Intraocular pressure: 18 mmHg · 30° field of view: 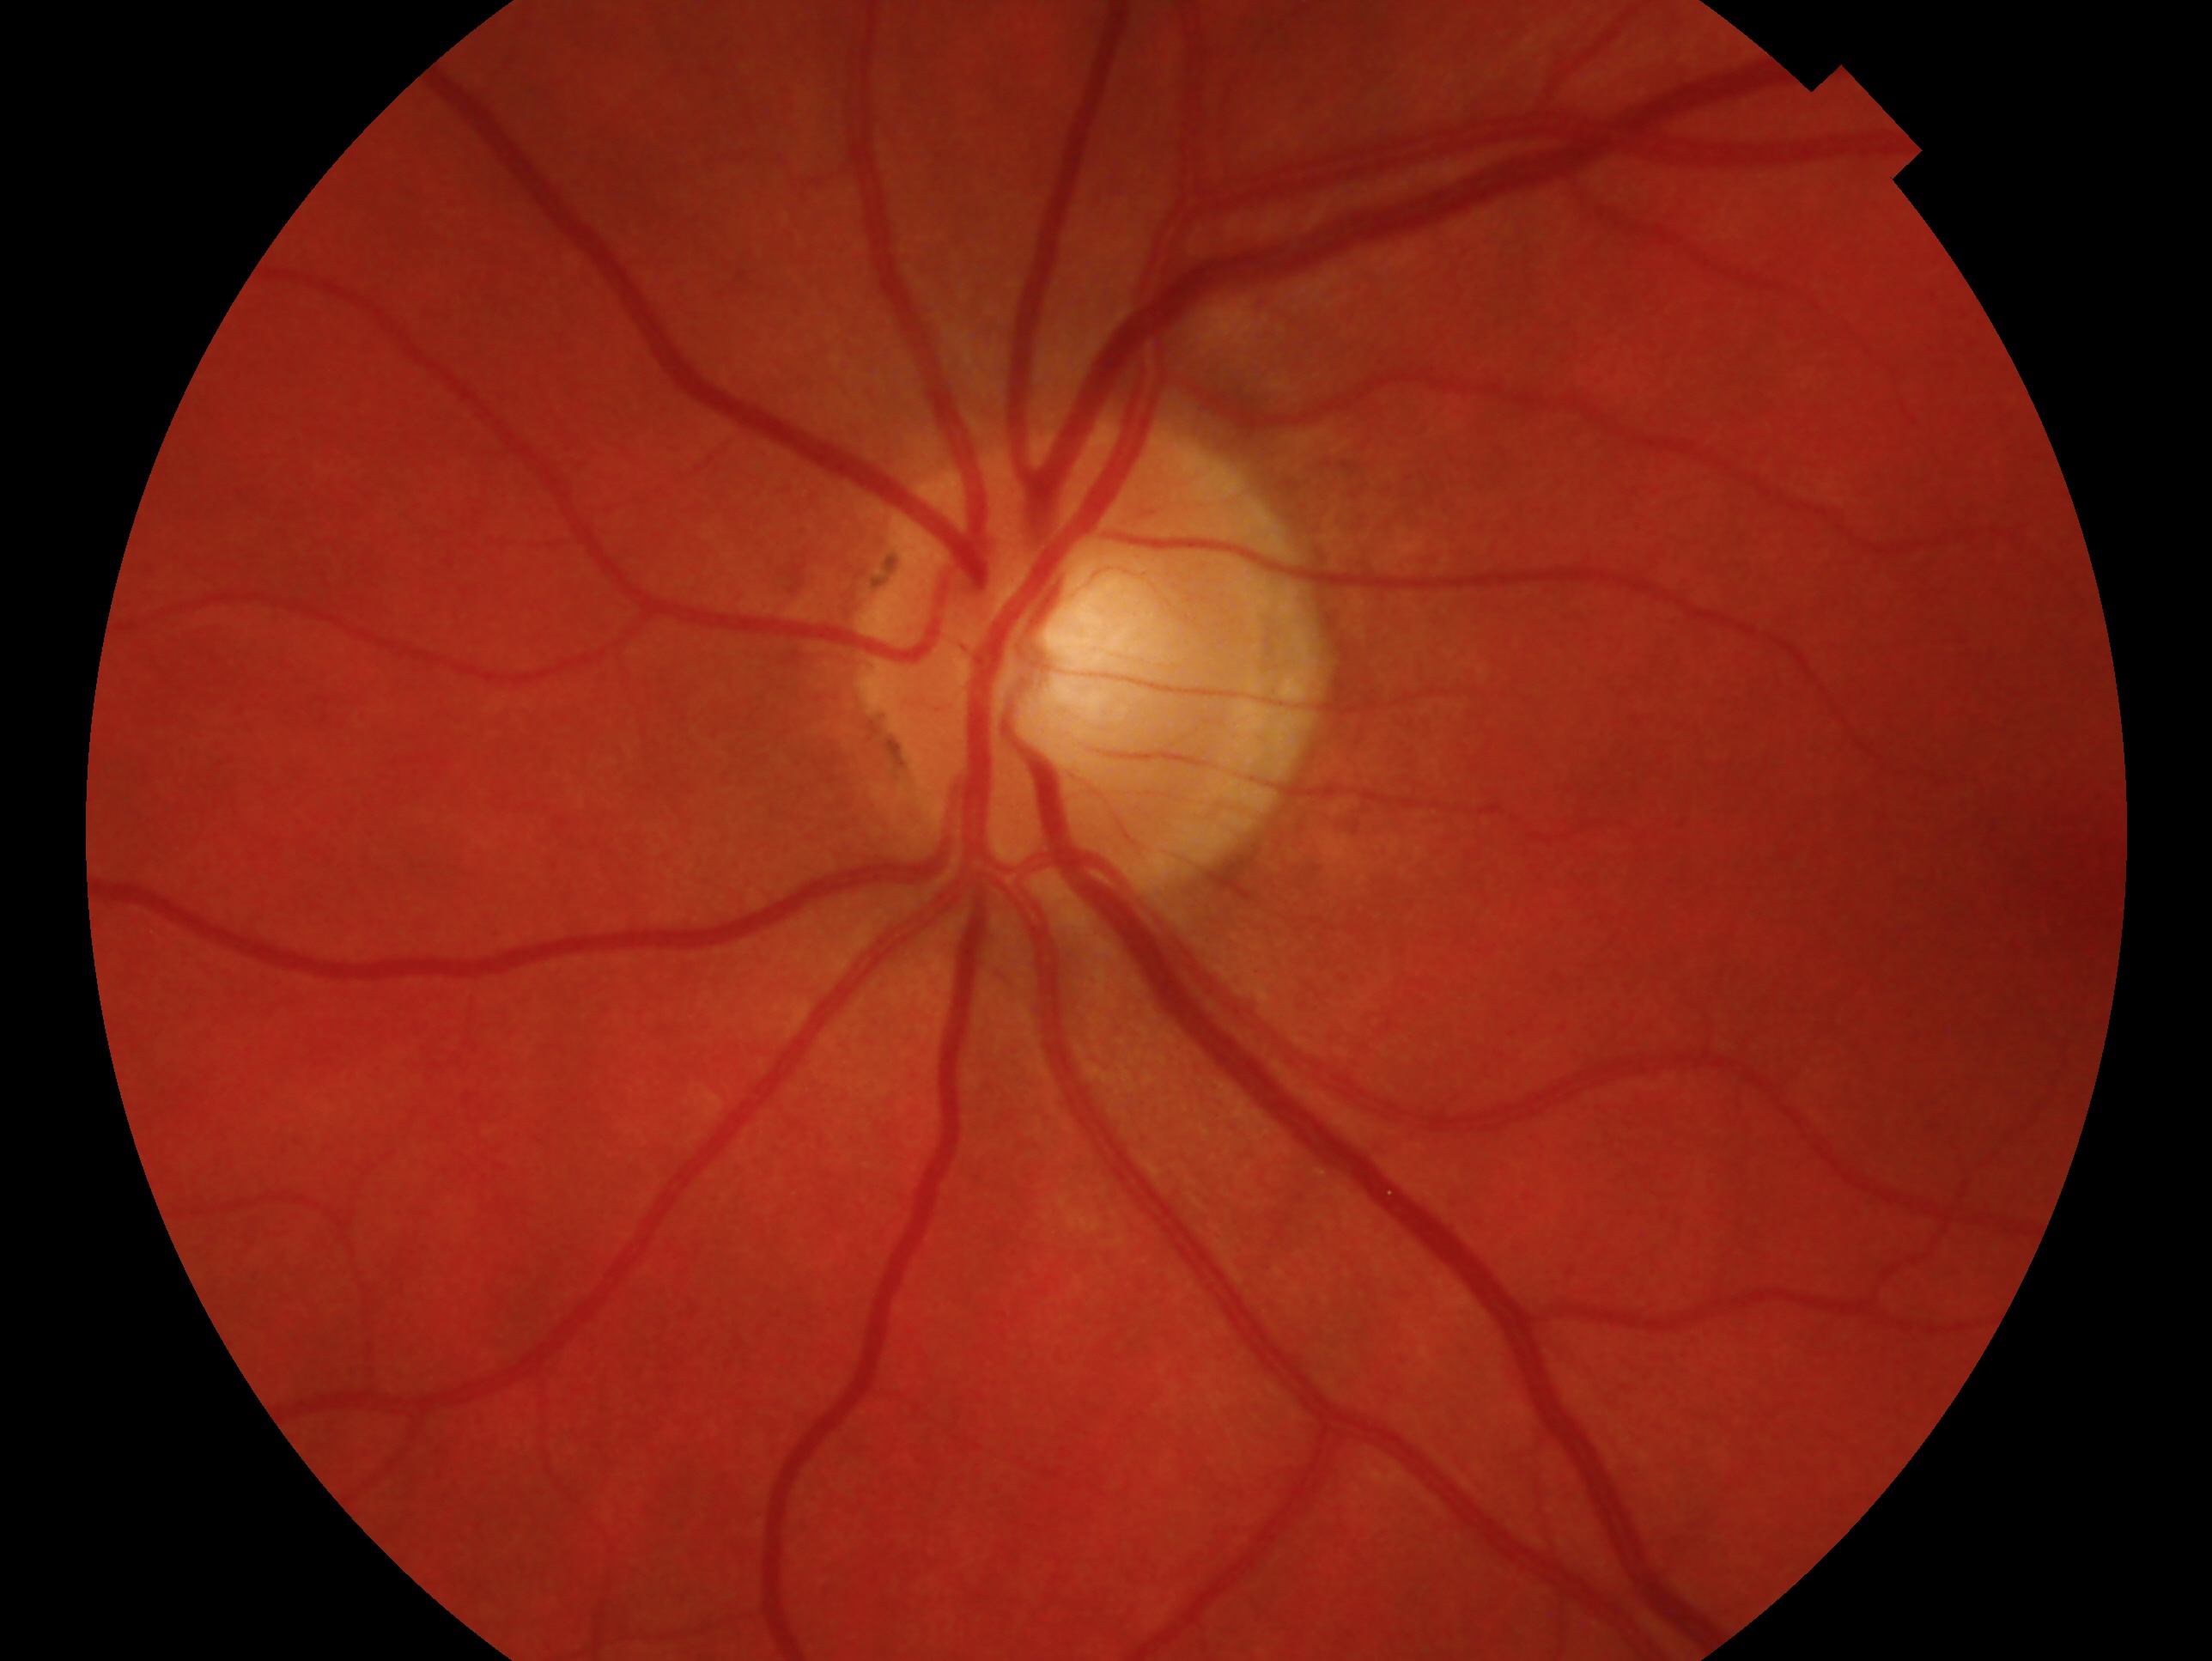
Glaucoma status: no signs of glaucoma. The image shows the left eye.